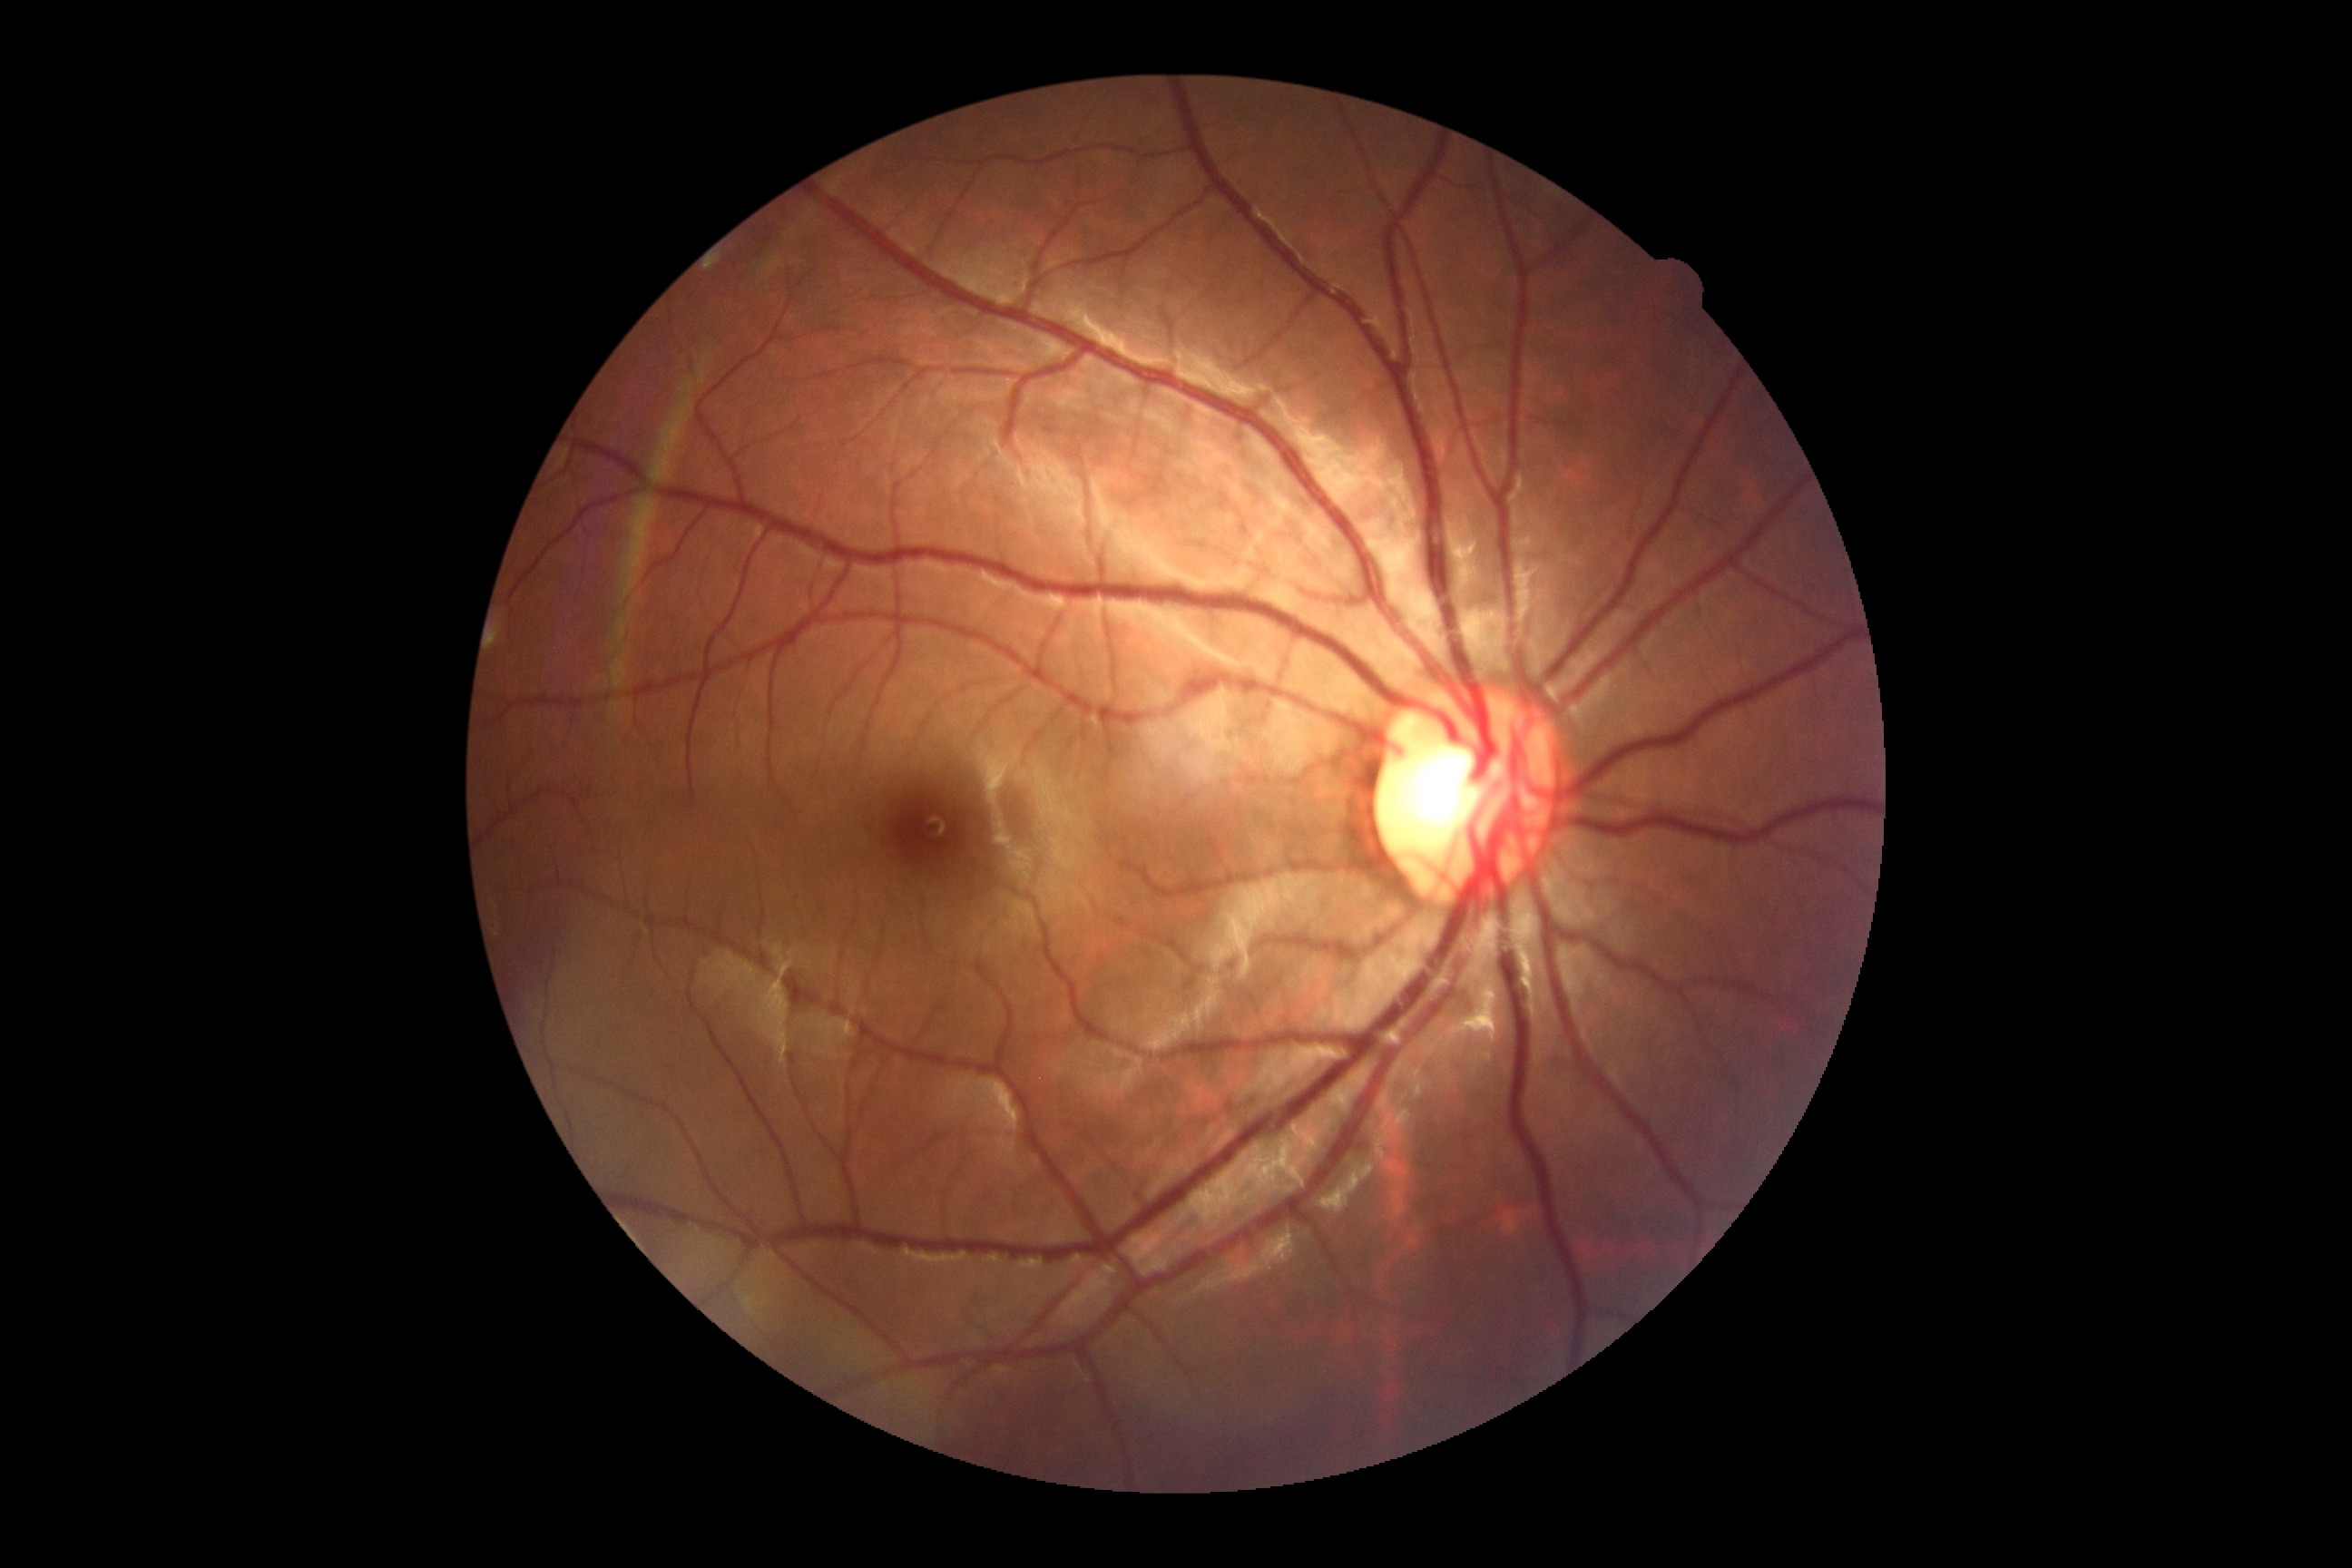
{"dr_grade": "no apparent retinopathy (grade 0)"}